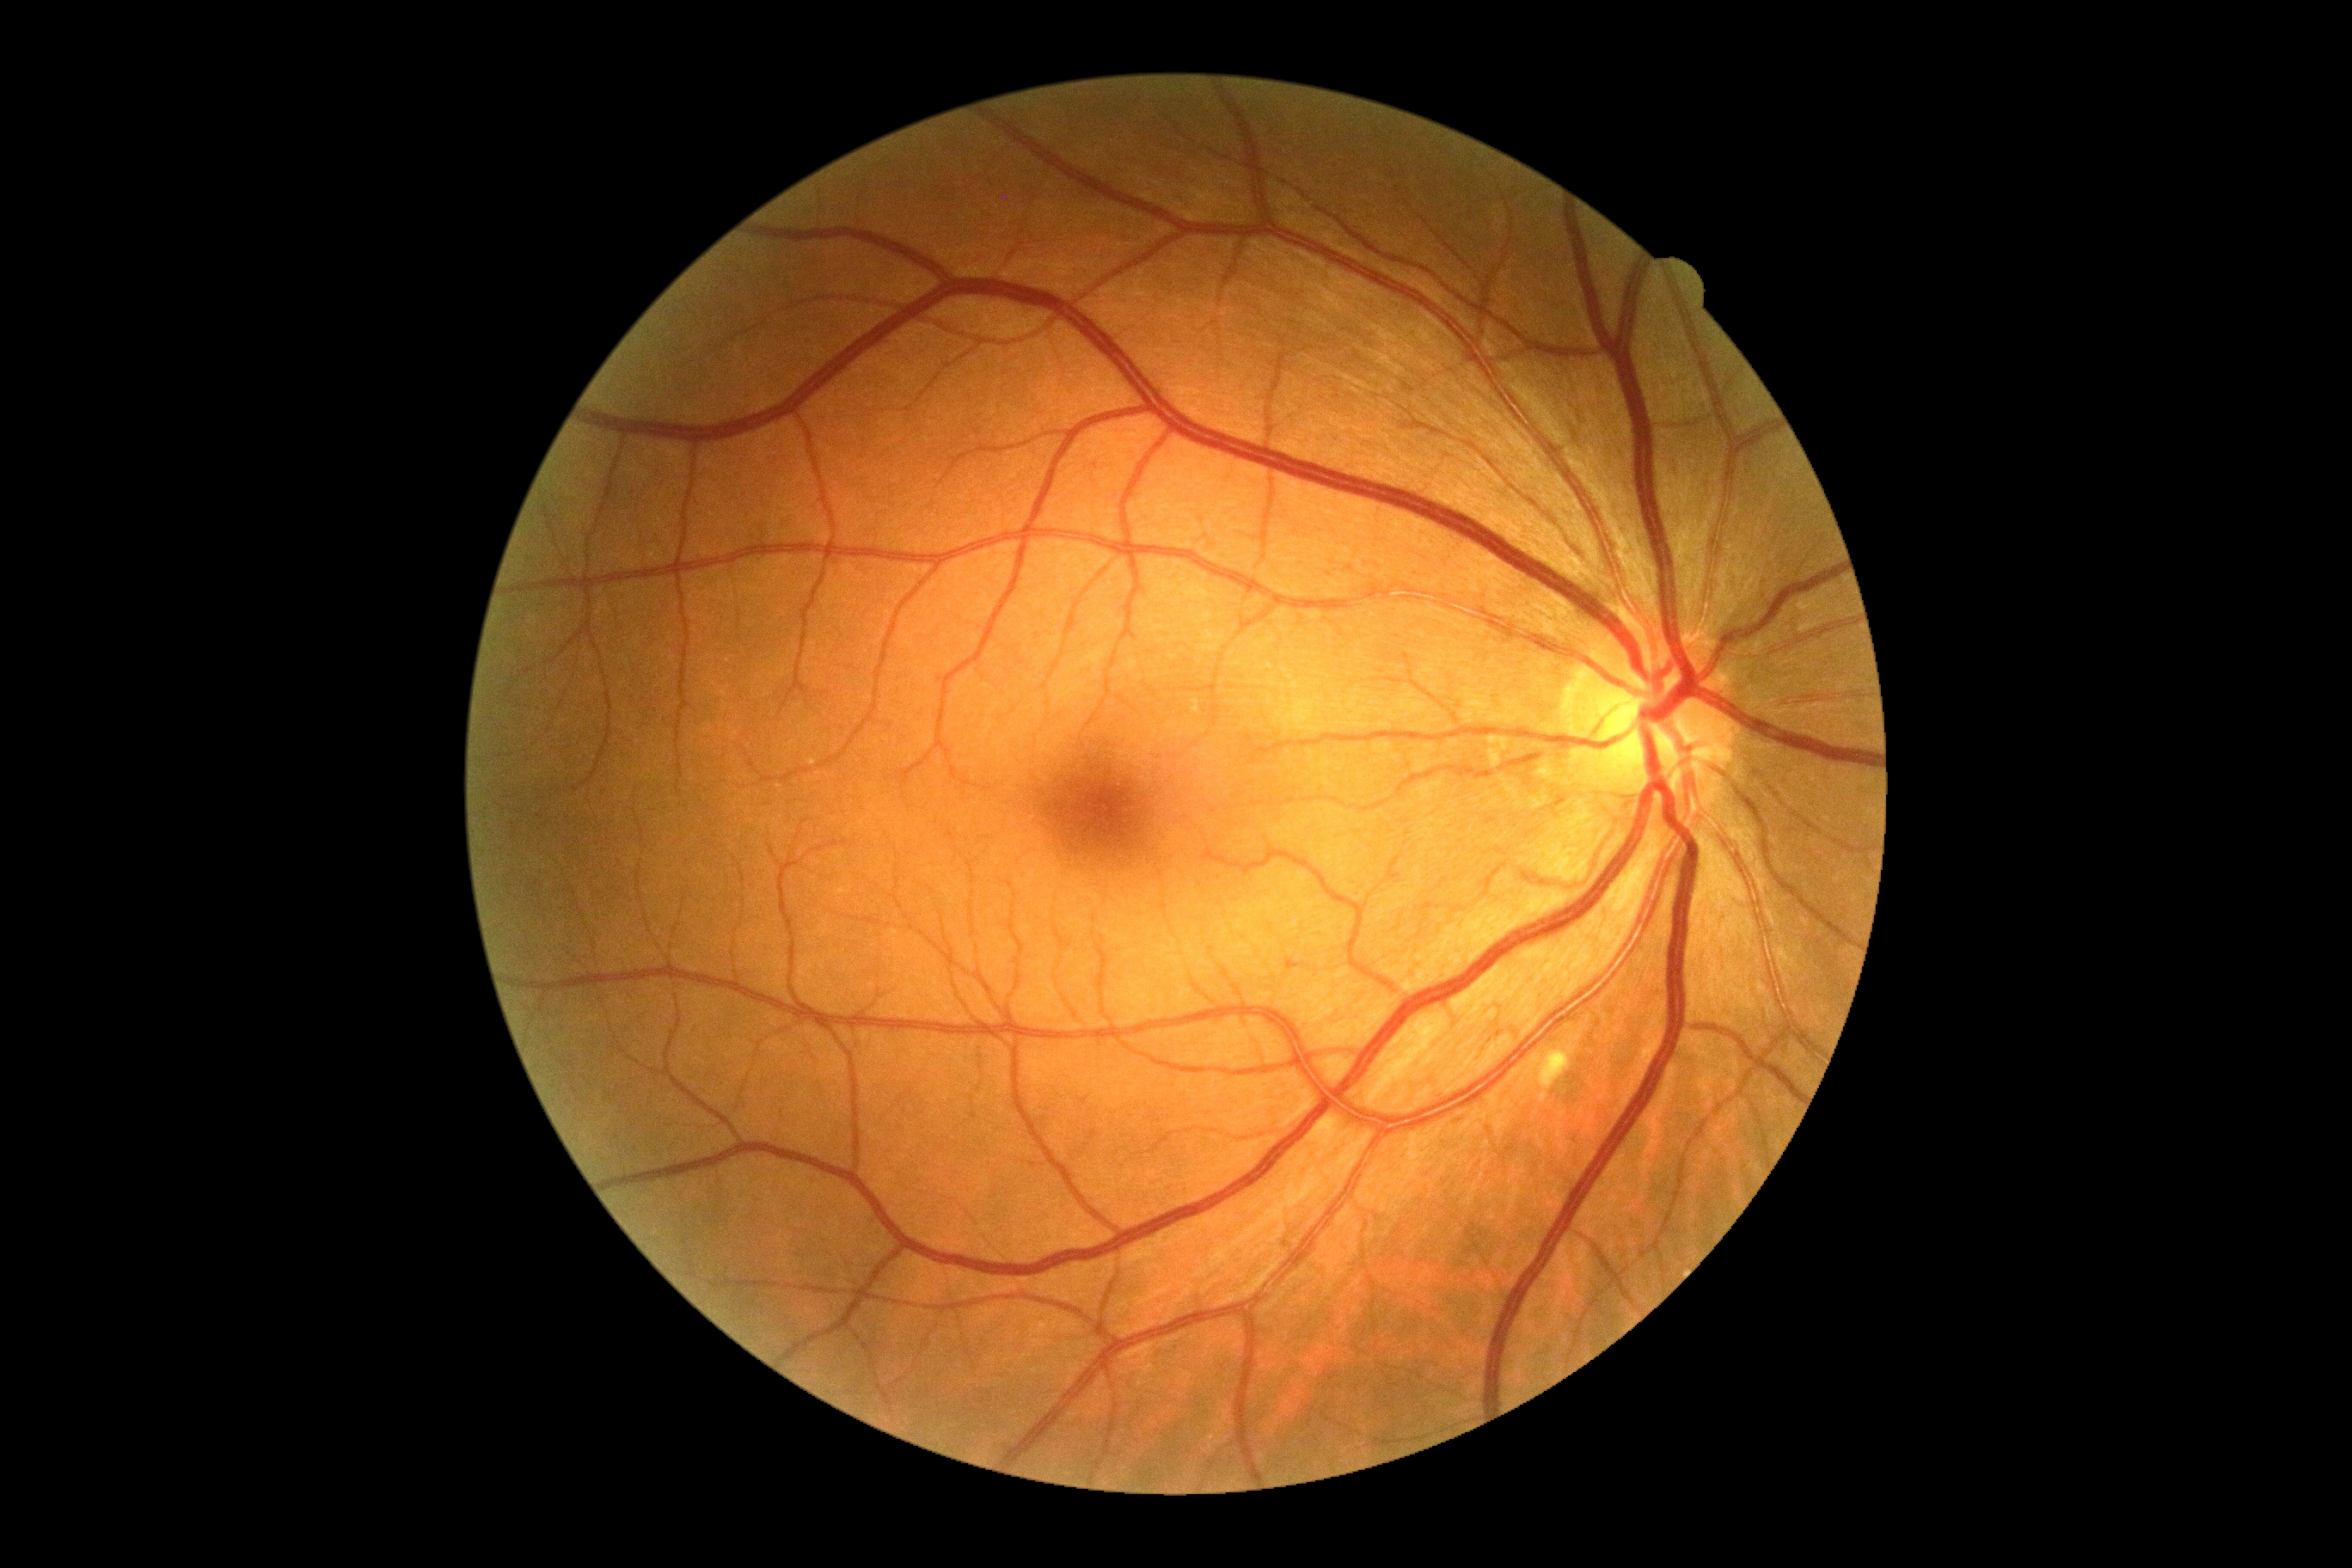 diabetic retinopathy grade = no apparent retinopathy (0), DR impression = no DR findings.